130° field of view (Clarity RetCam 3); wide-field fundus photograph of an infant; 640 x 480 pixels:
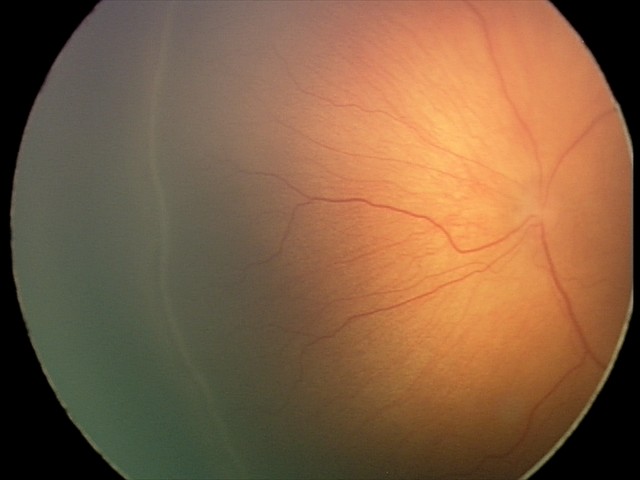
Plus disease absent. Series diagnosed as ROP stage 2 — ridge with height and width at the demarcation line.